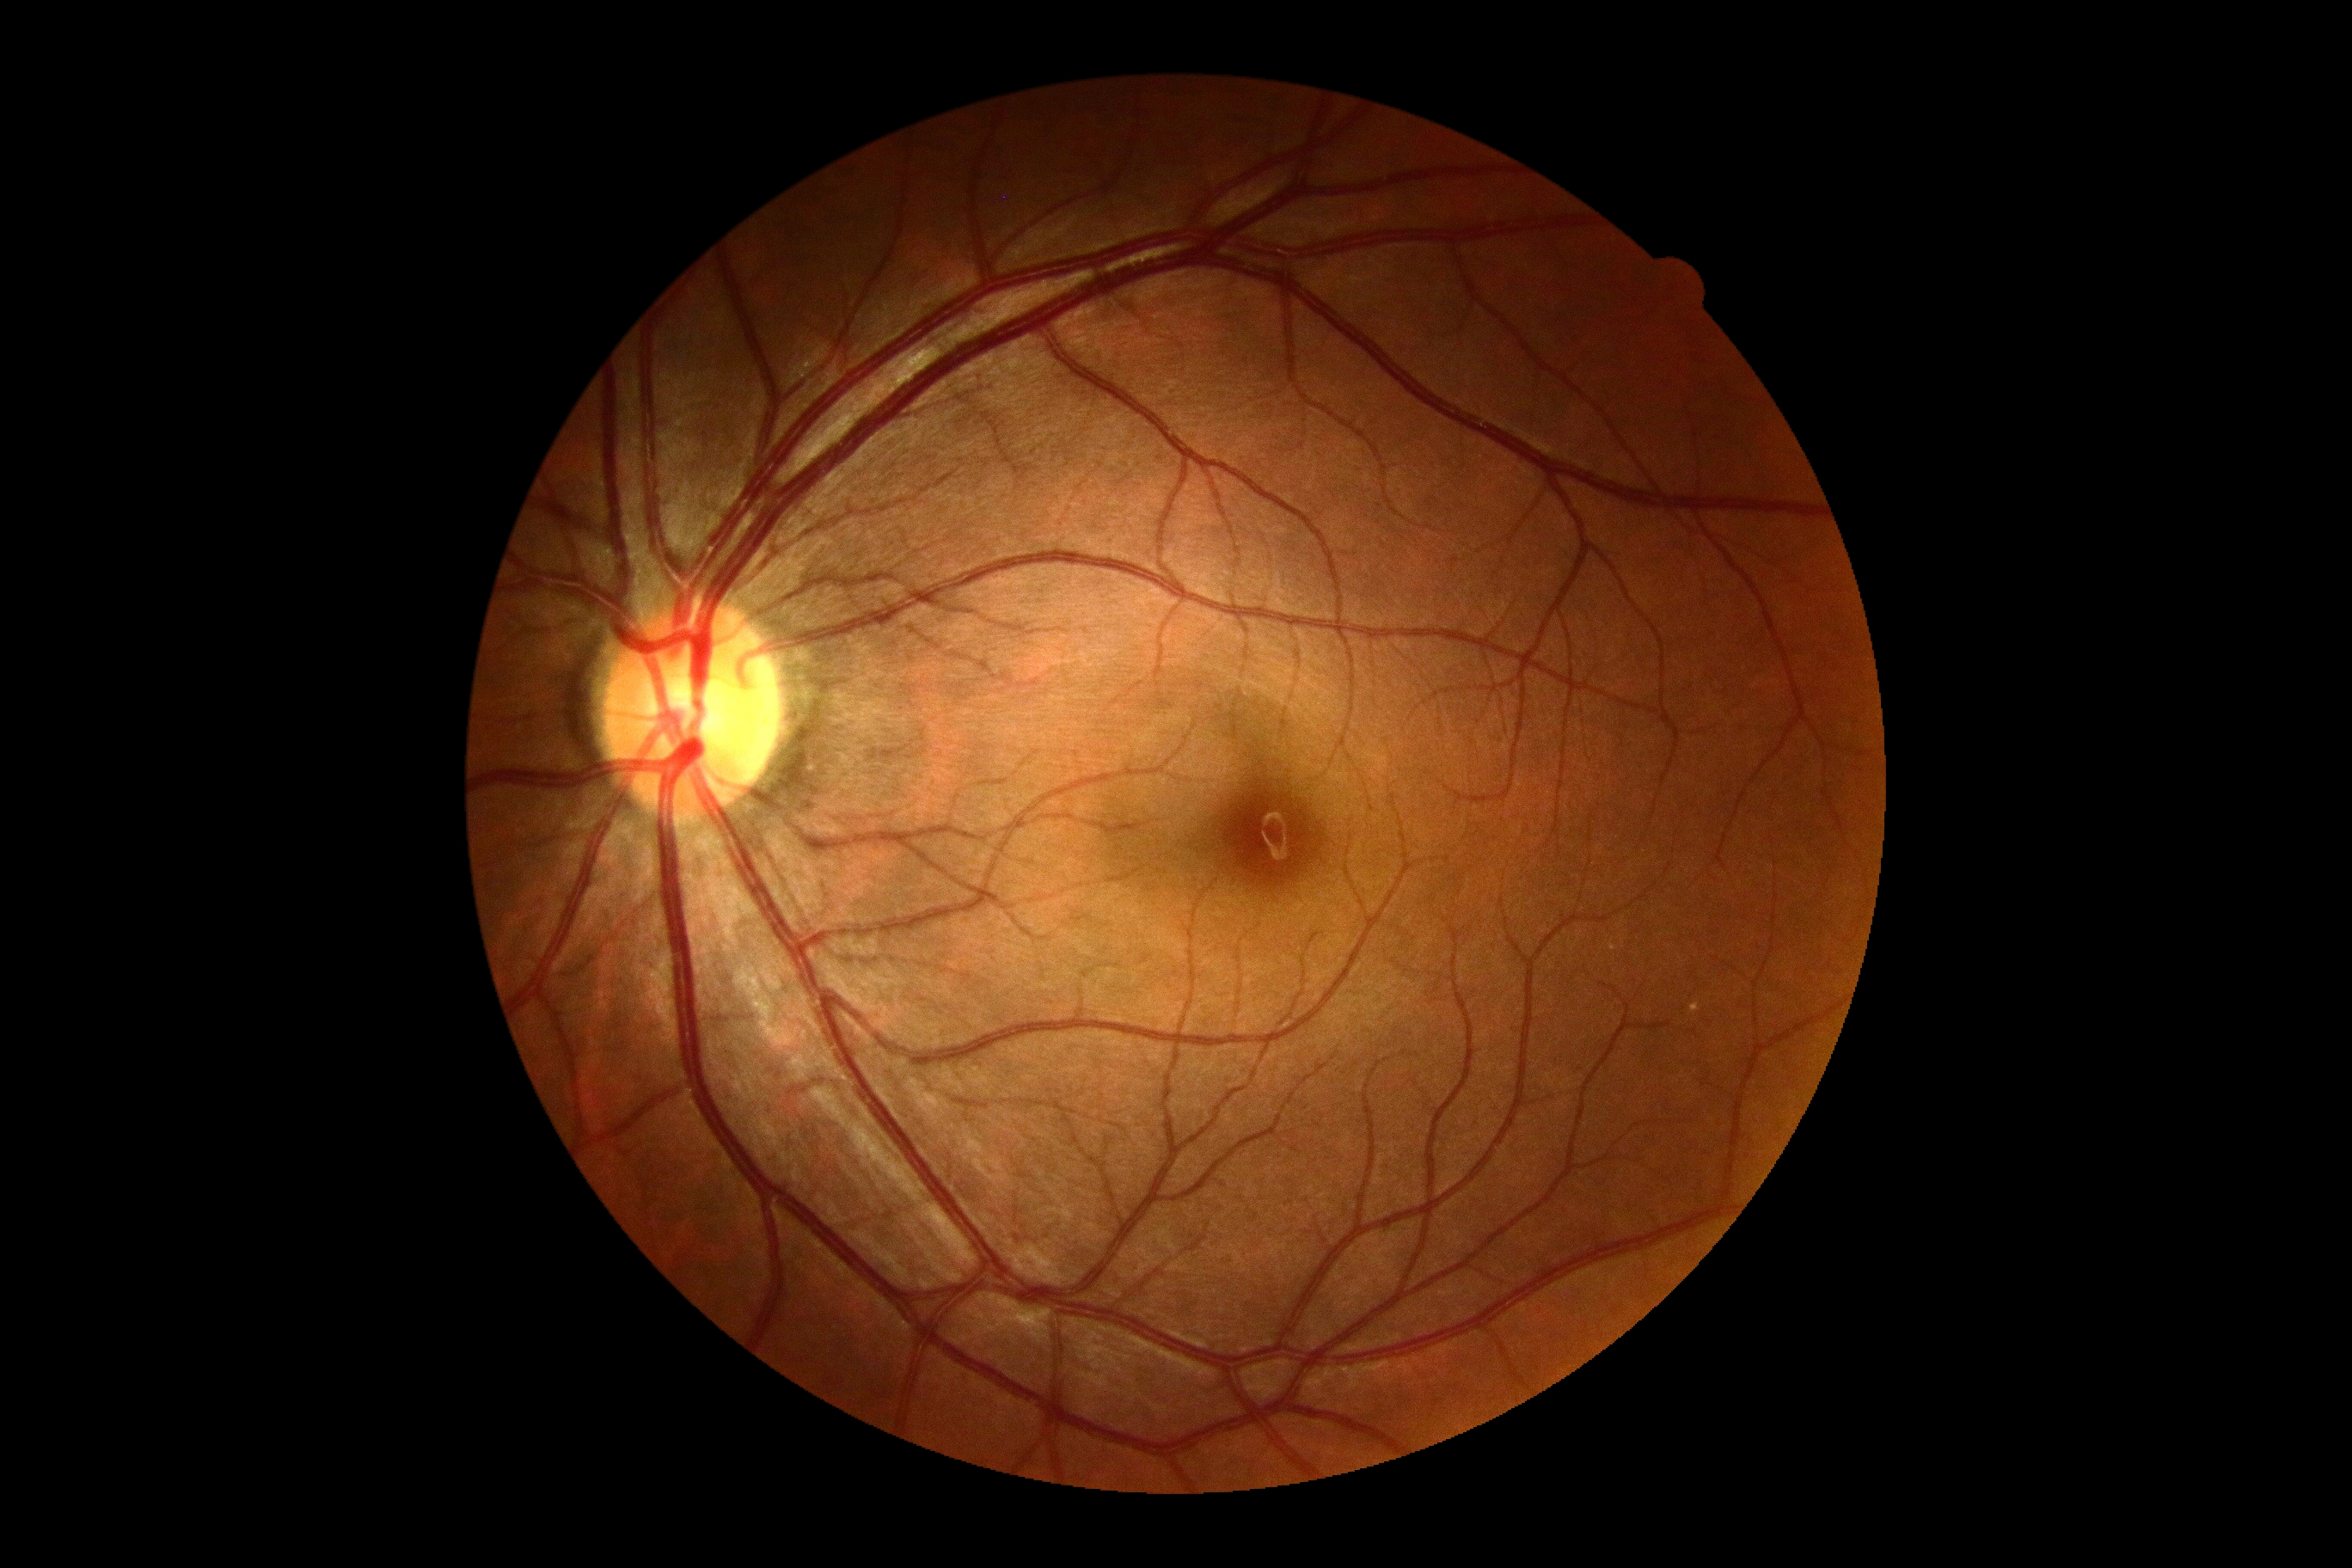 {"dr_impression": "no apparent DR", "dr_grade": "grade 0 (no apparent retinopathy)"}